Pediatric wide-field fundus photograph.
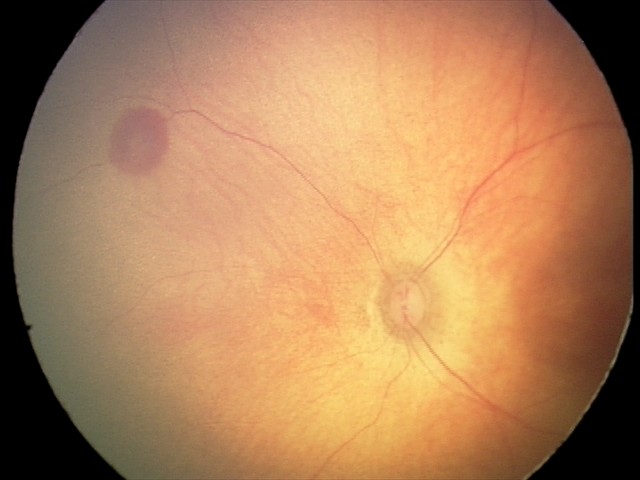 Finding: retinal hemorrhages.